Wide-field fundus photograph of an infant. 640x480px.
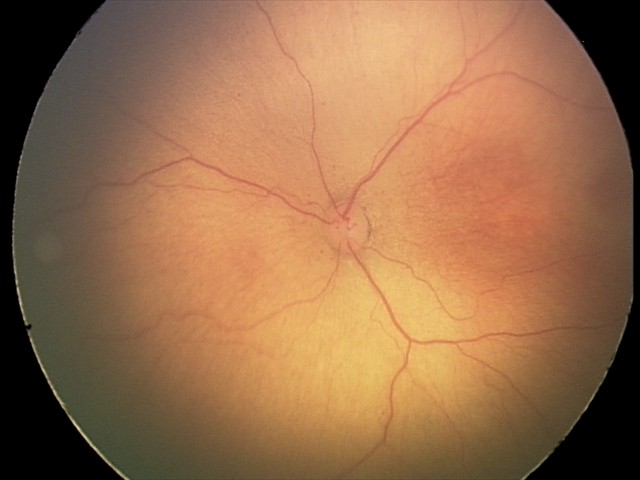 Plus disease absent.
From an examination with diagnosis of ROP stage 2 — ridge with height and width at the demarcation line.